Image size 2048x1536.
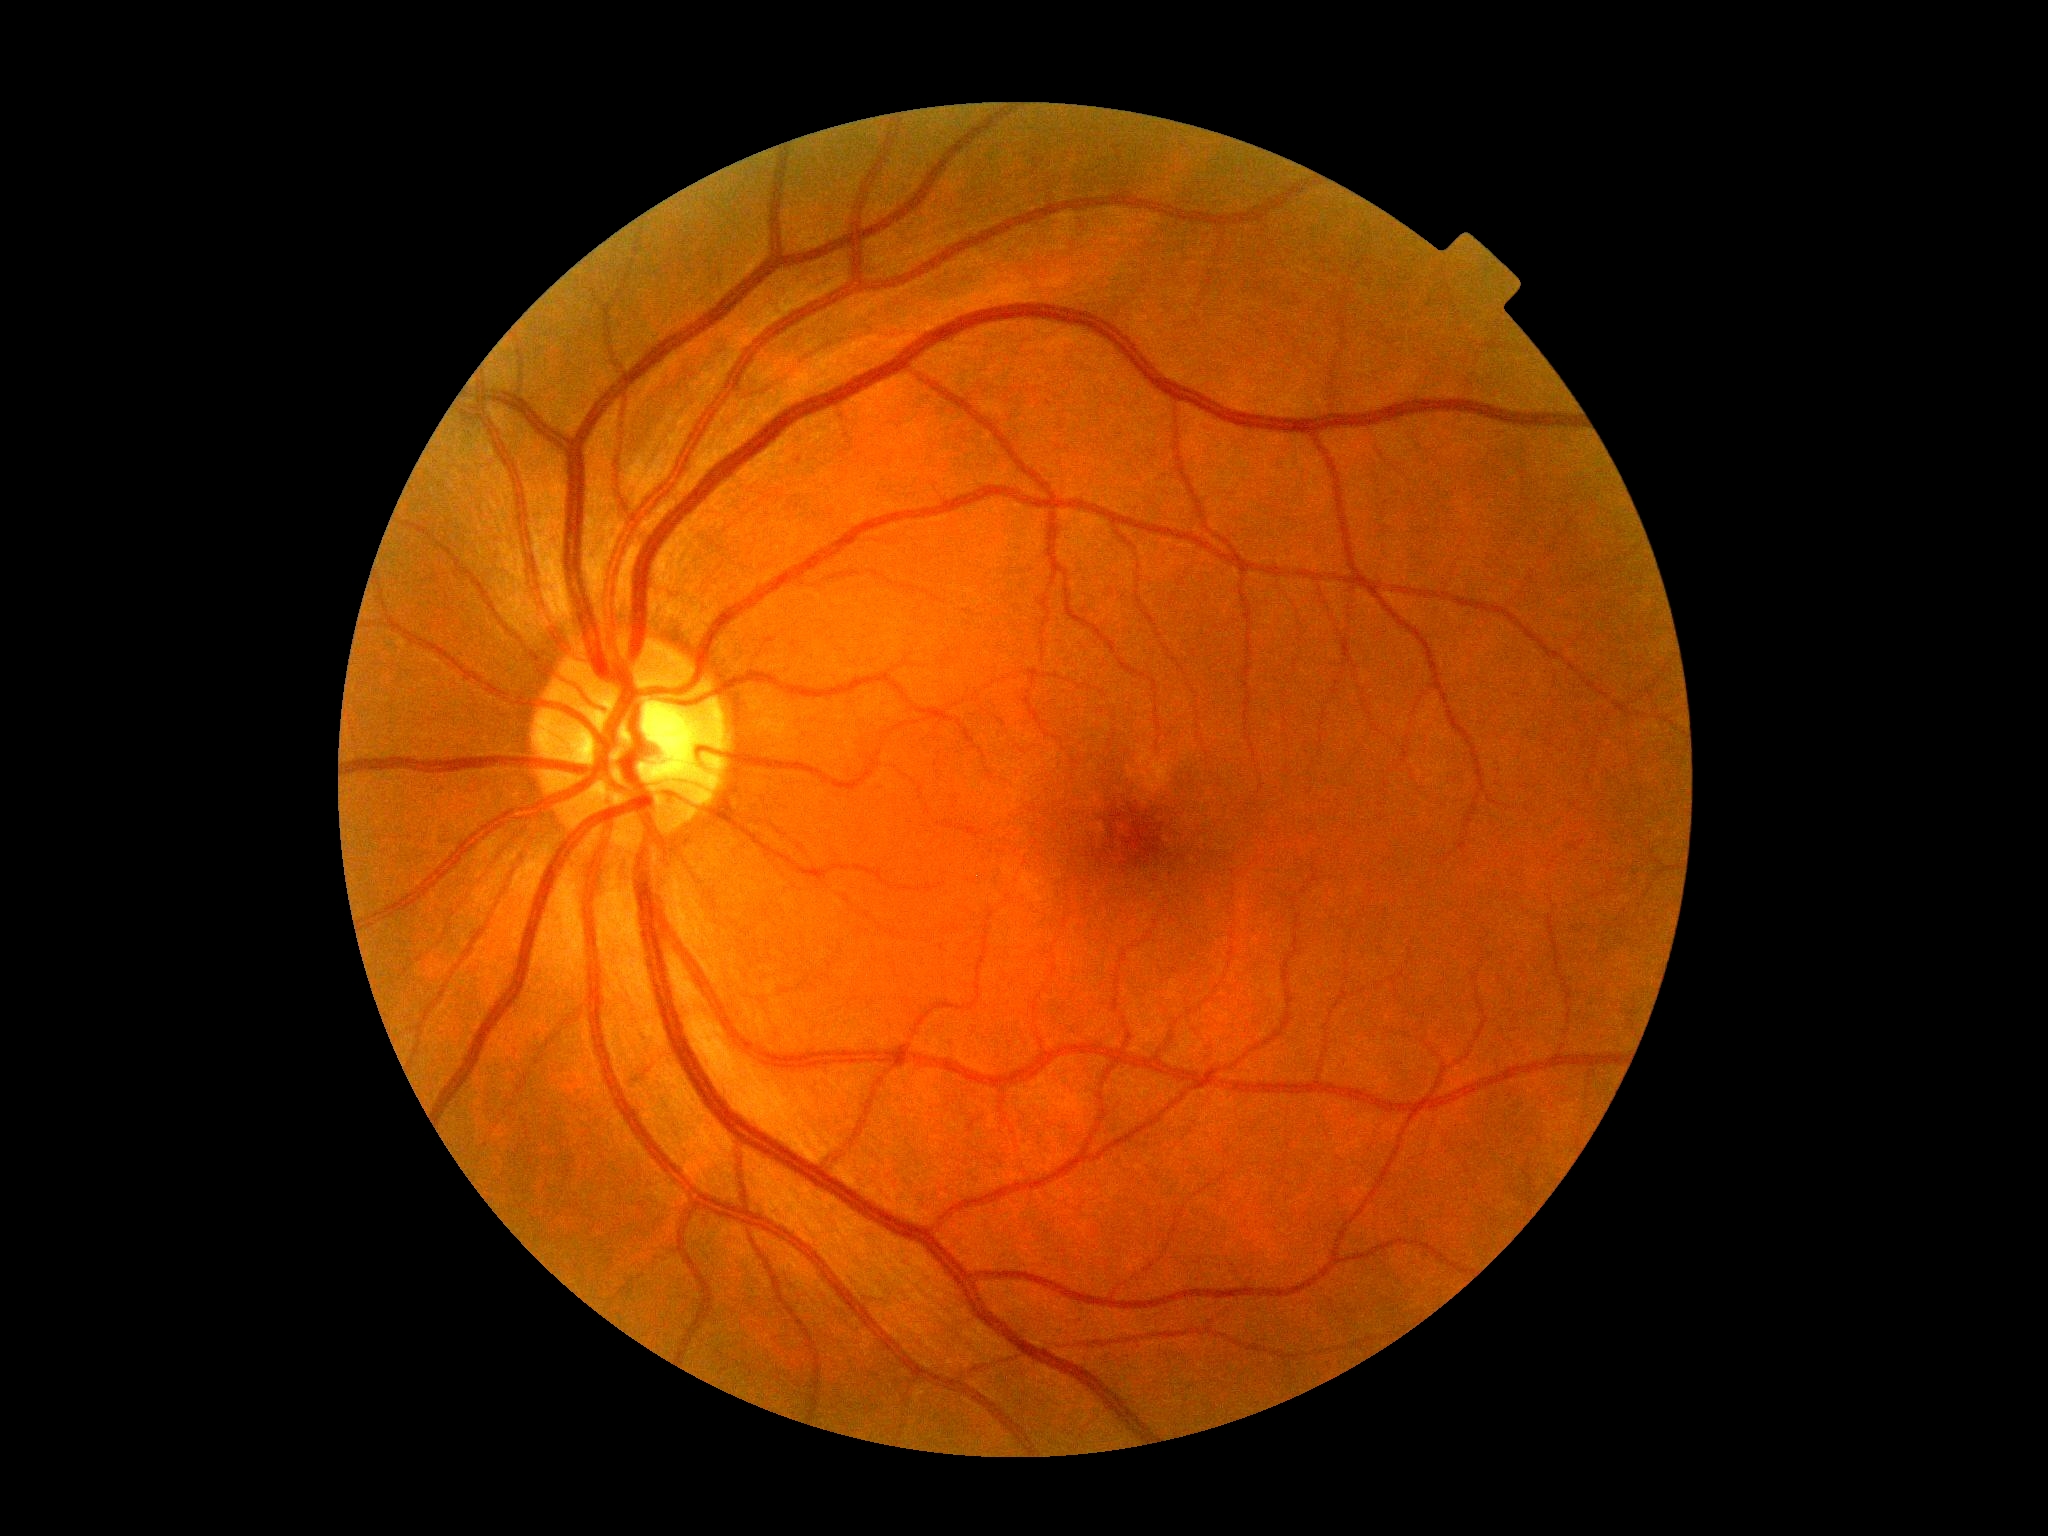
No signs of diabetic retinopathy.
Diabetic retinopathy is no apparent diabetic retinopathy (grade 0).